Image size 2346x1568 · 45° field of view · color fundus photograph: 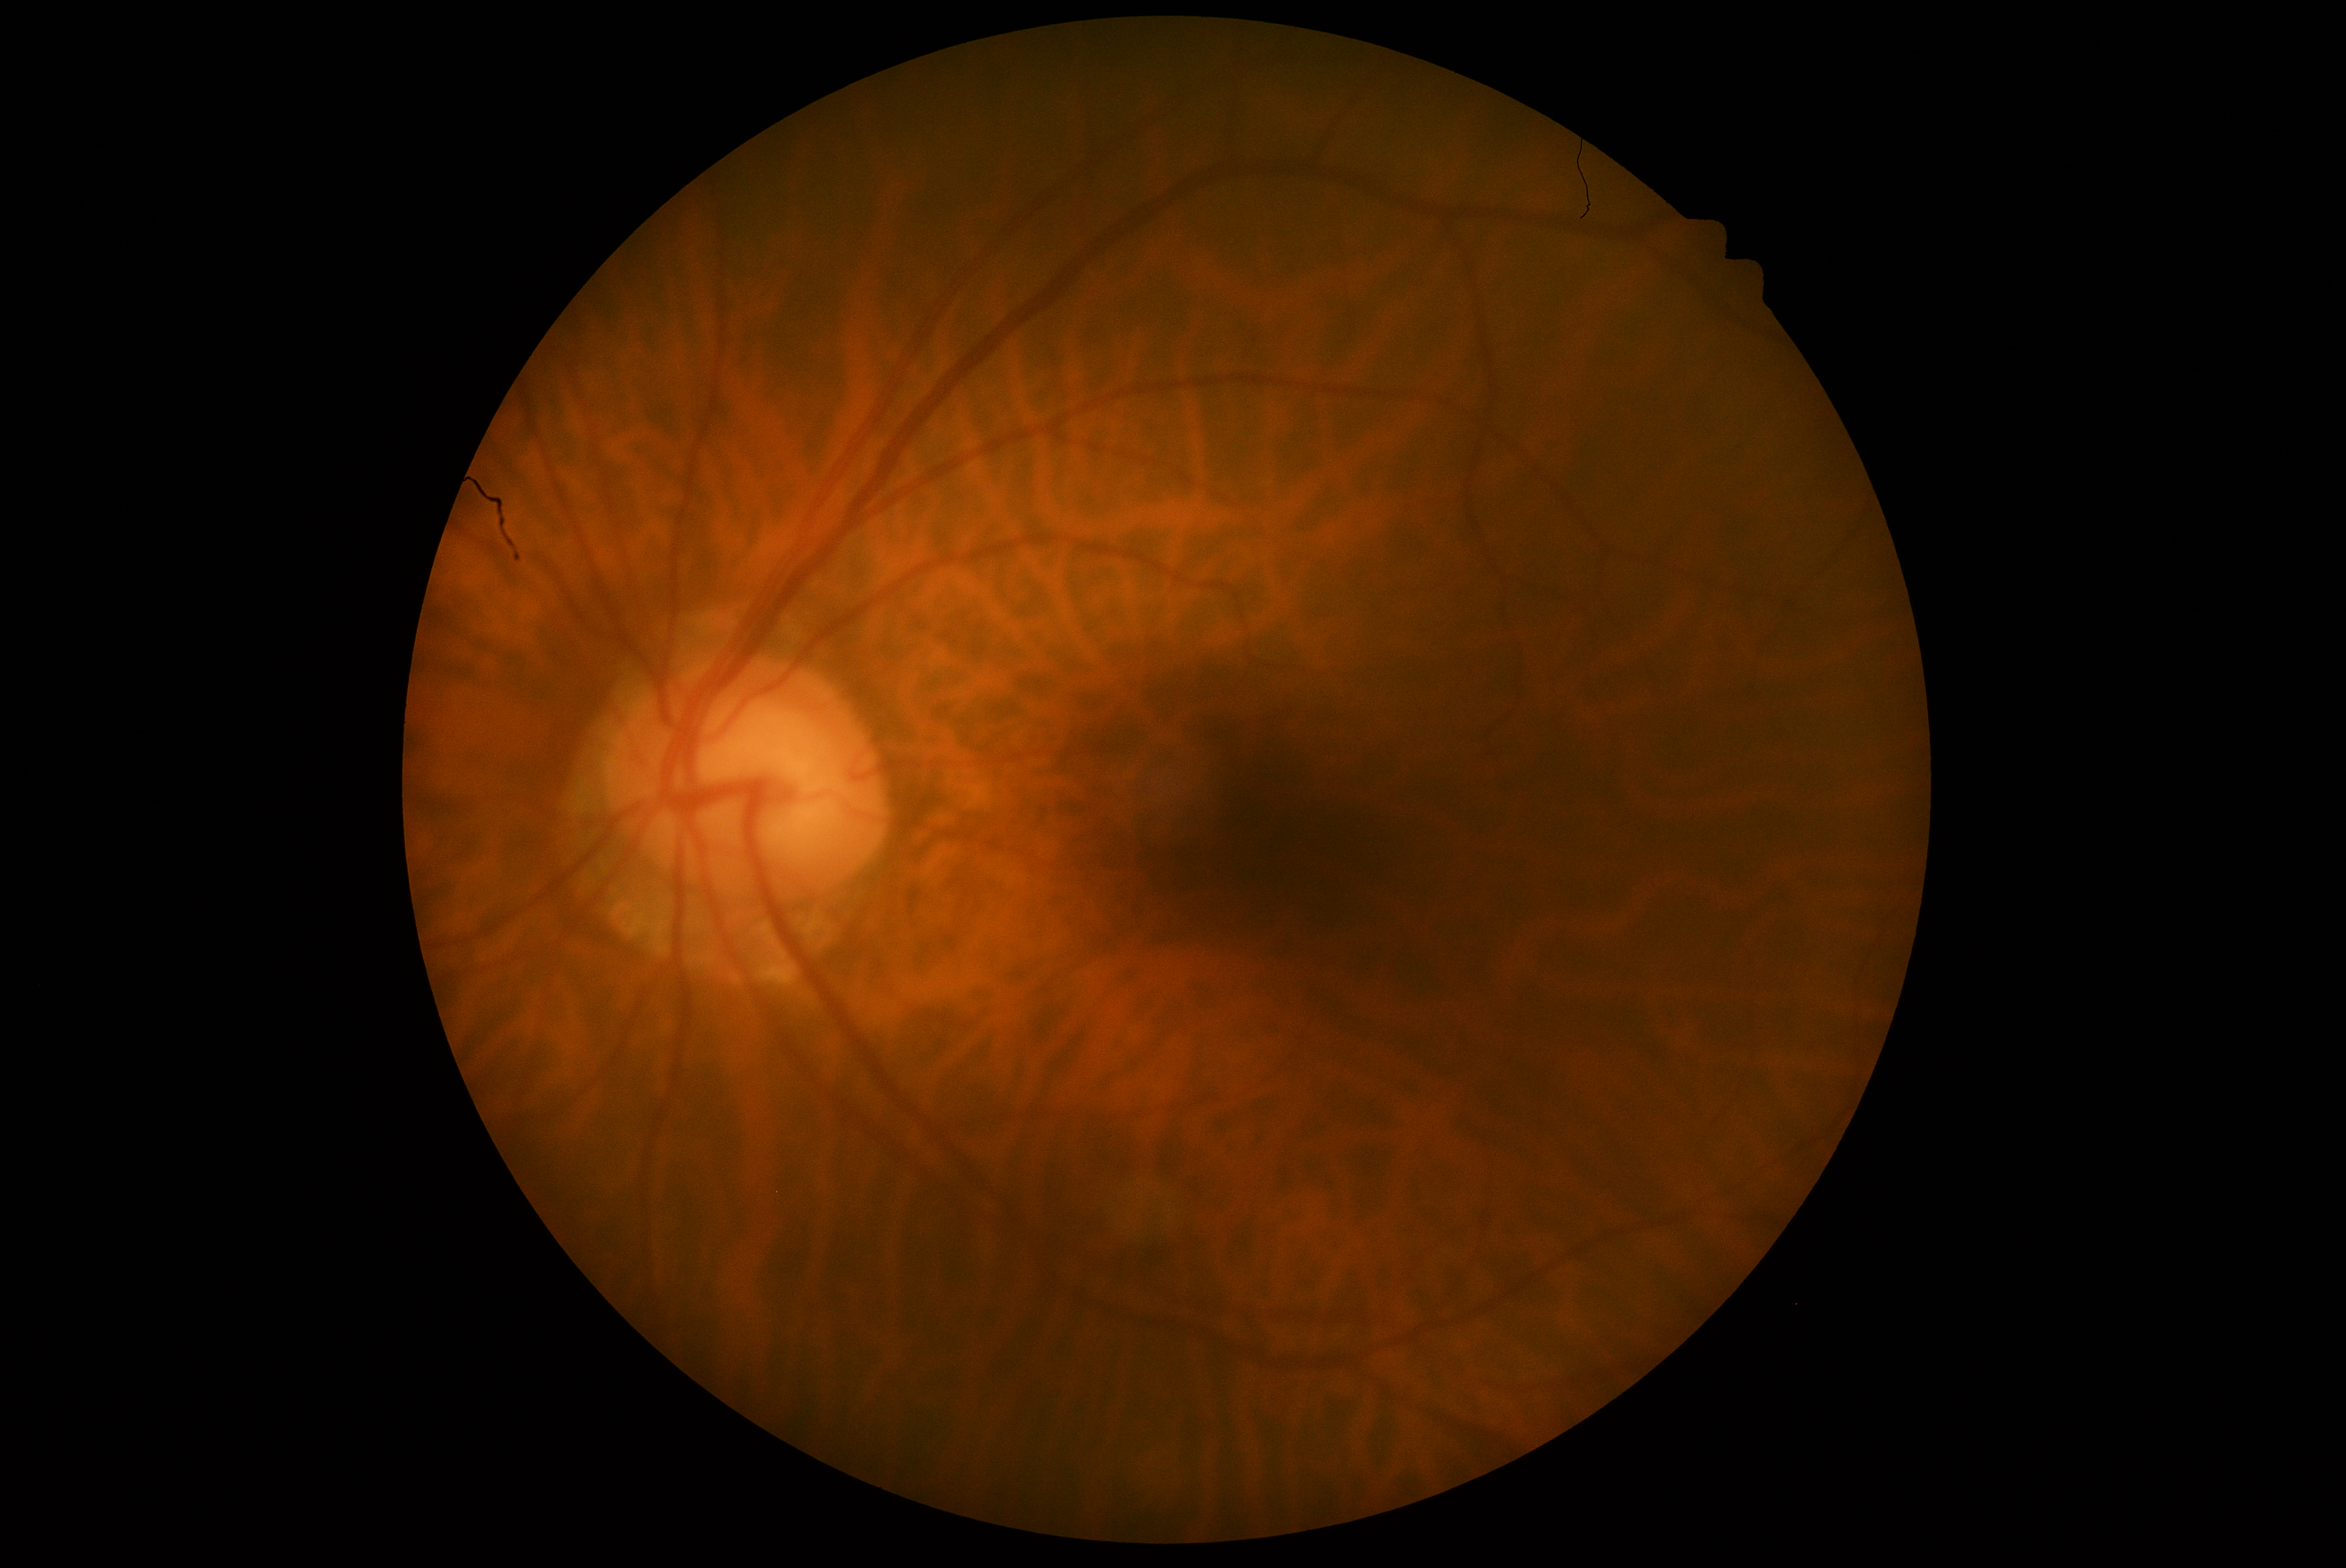
DR grade: no apparent retinopathy (0).